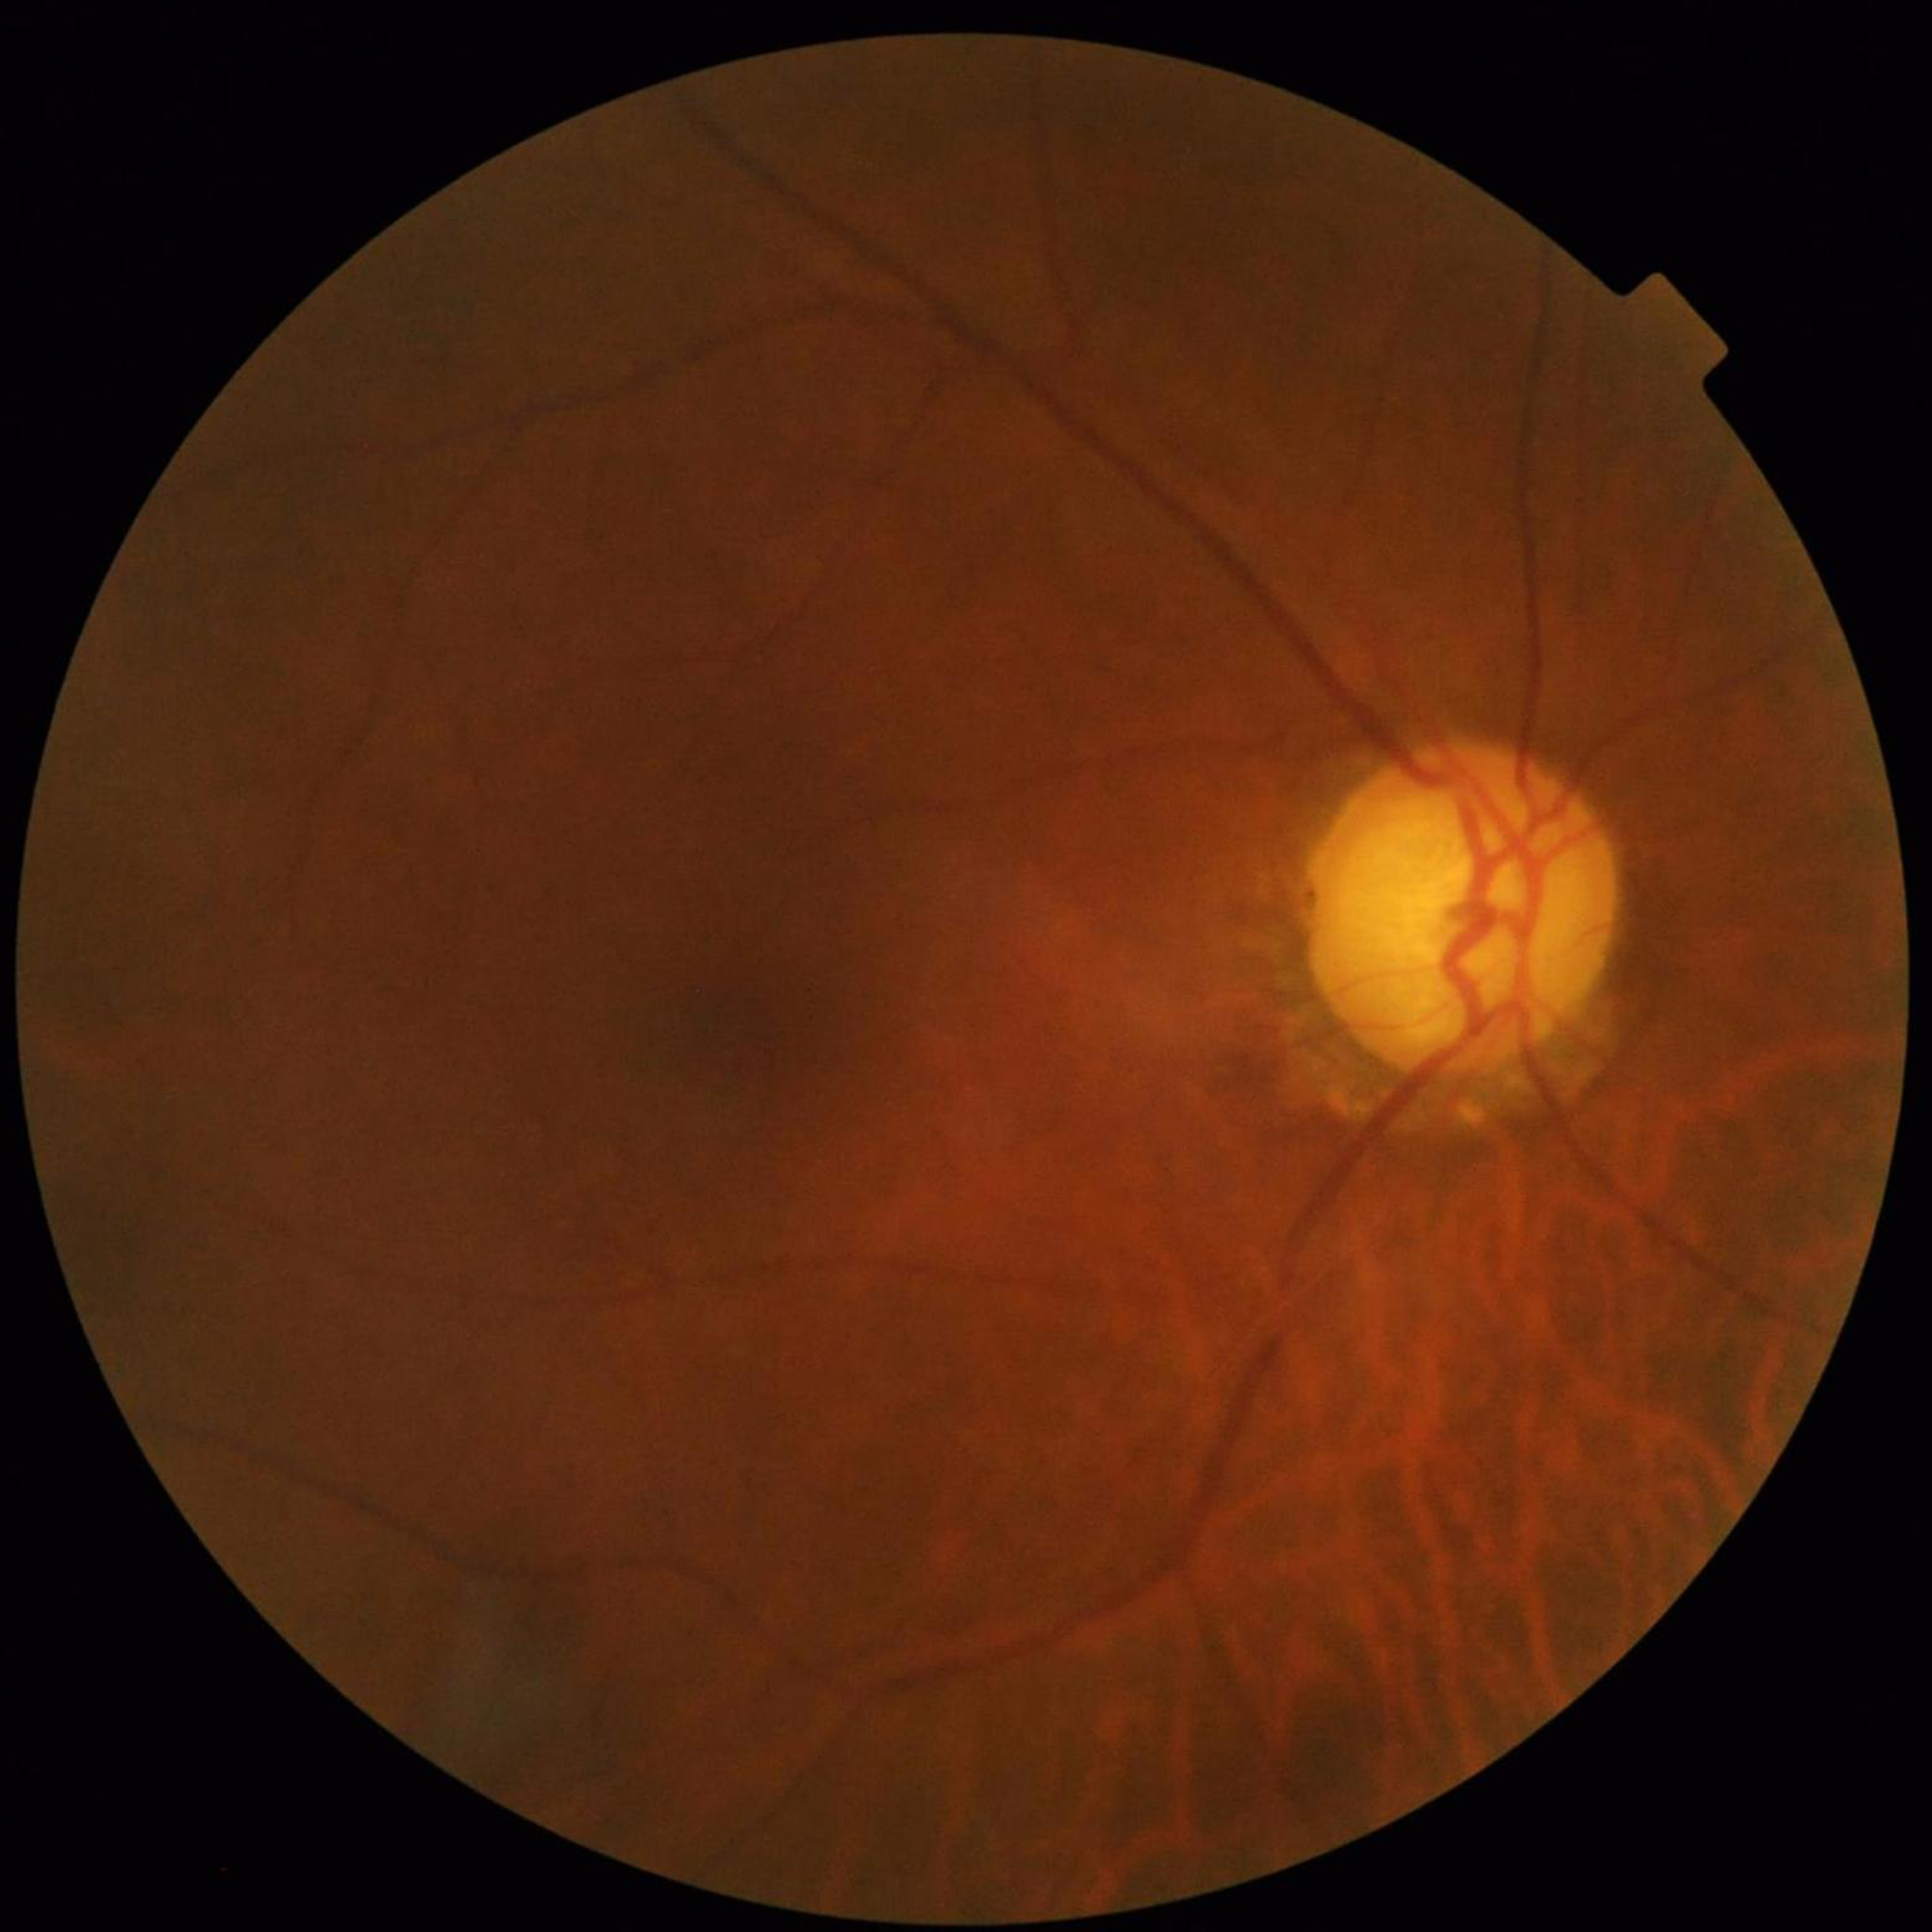 Automated quality assessment: suboptimal — blur.
Color fundus photograph from a patient diagnosed with glaucoma.